848 x 848 pixels; camera: NIDEK AFC-230; 45° FOV.
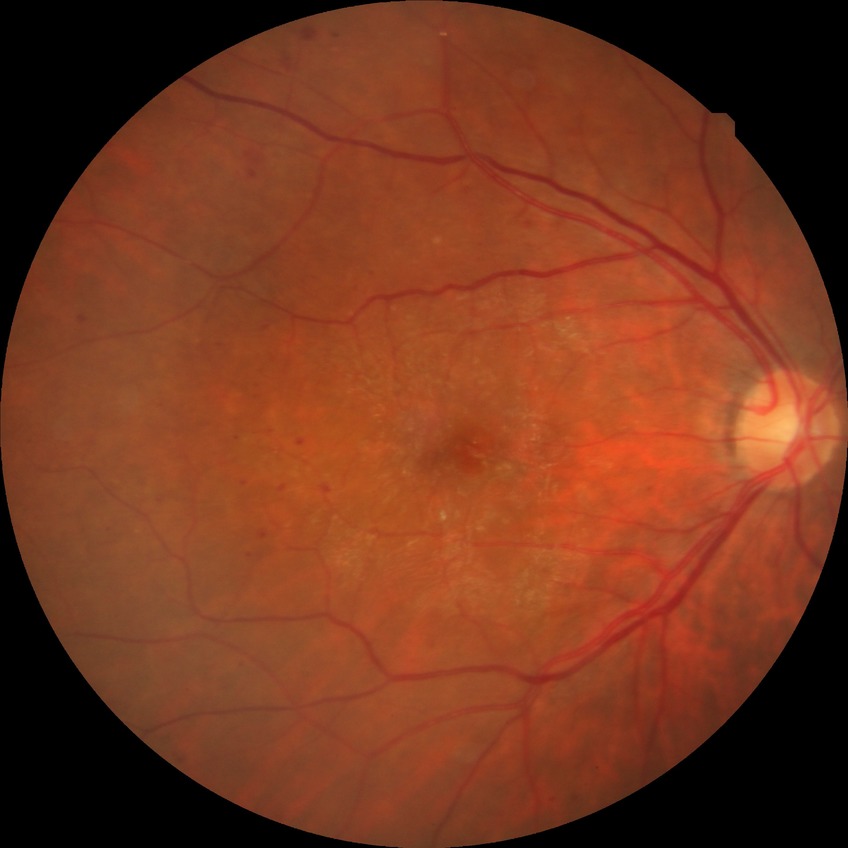

Assessment:
* DR severity: SDR